CFP · 45° field of view · 2352x1568px: 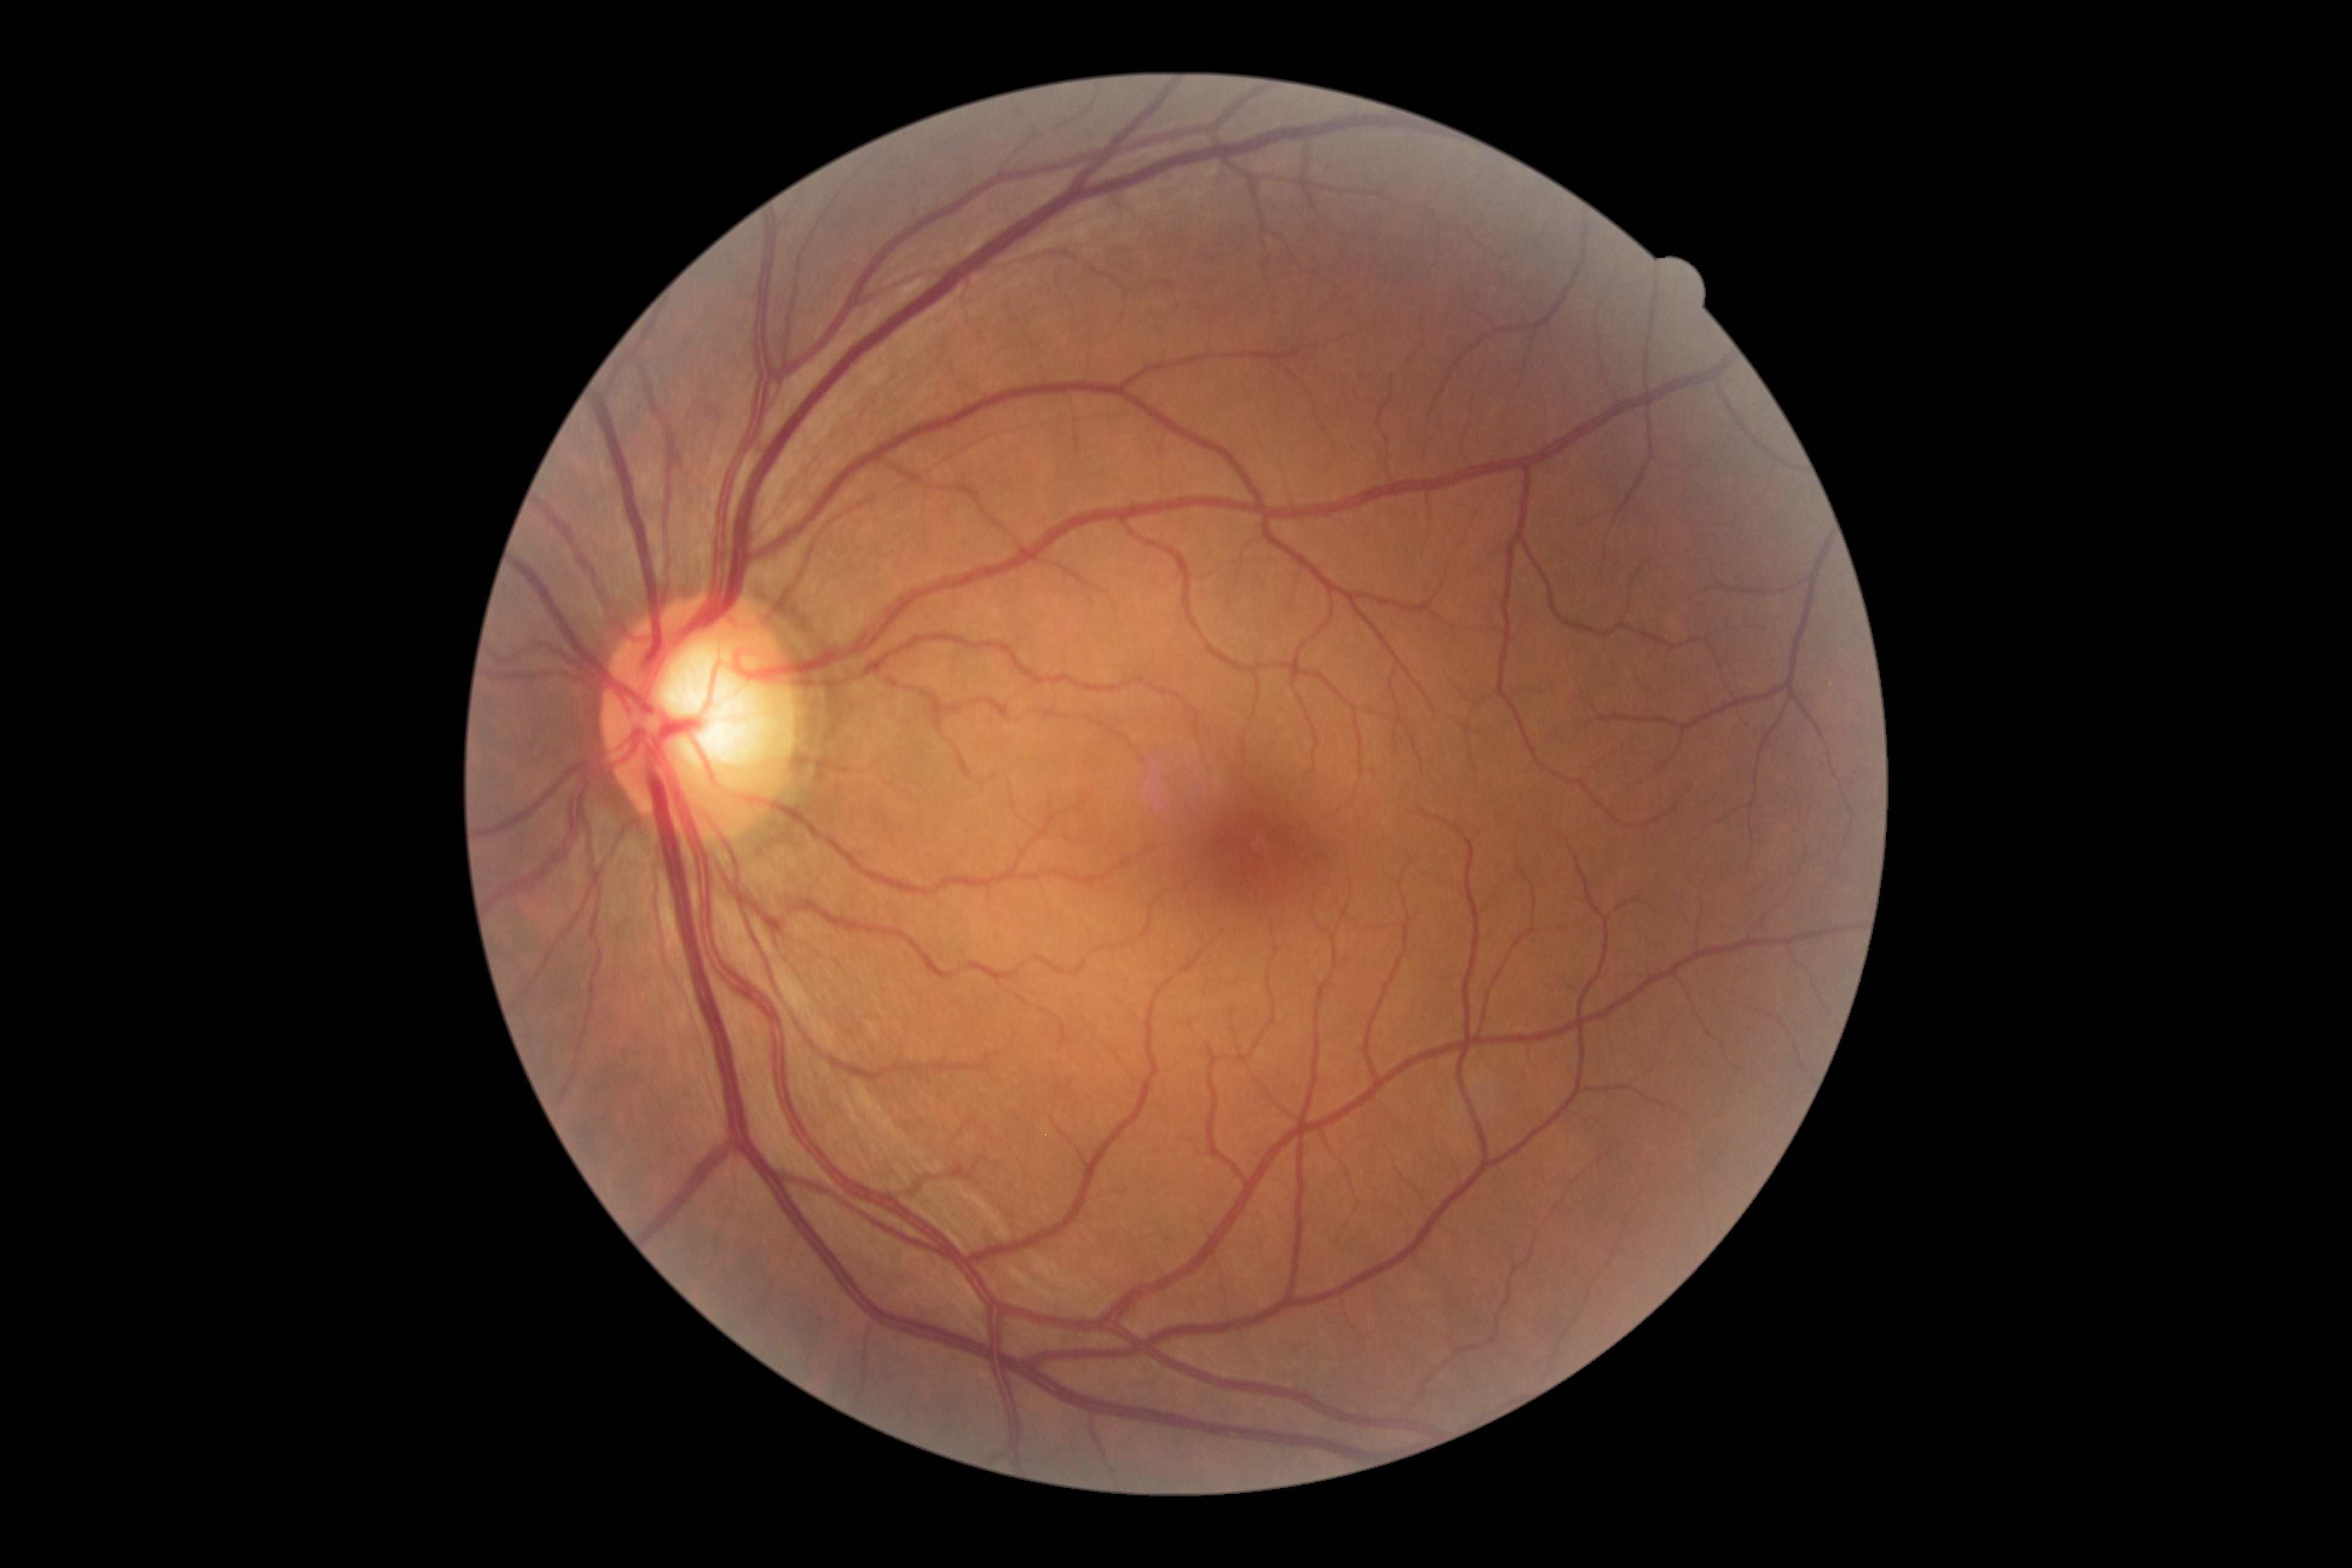 DR is grade 0 (no apparent retinopathy).